2352 by 1568 pixels — 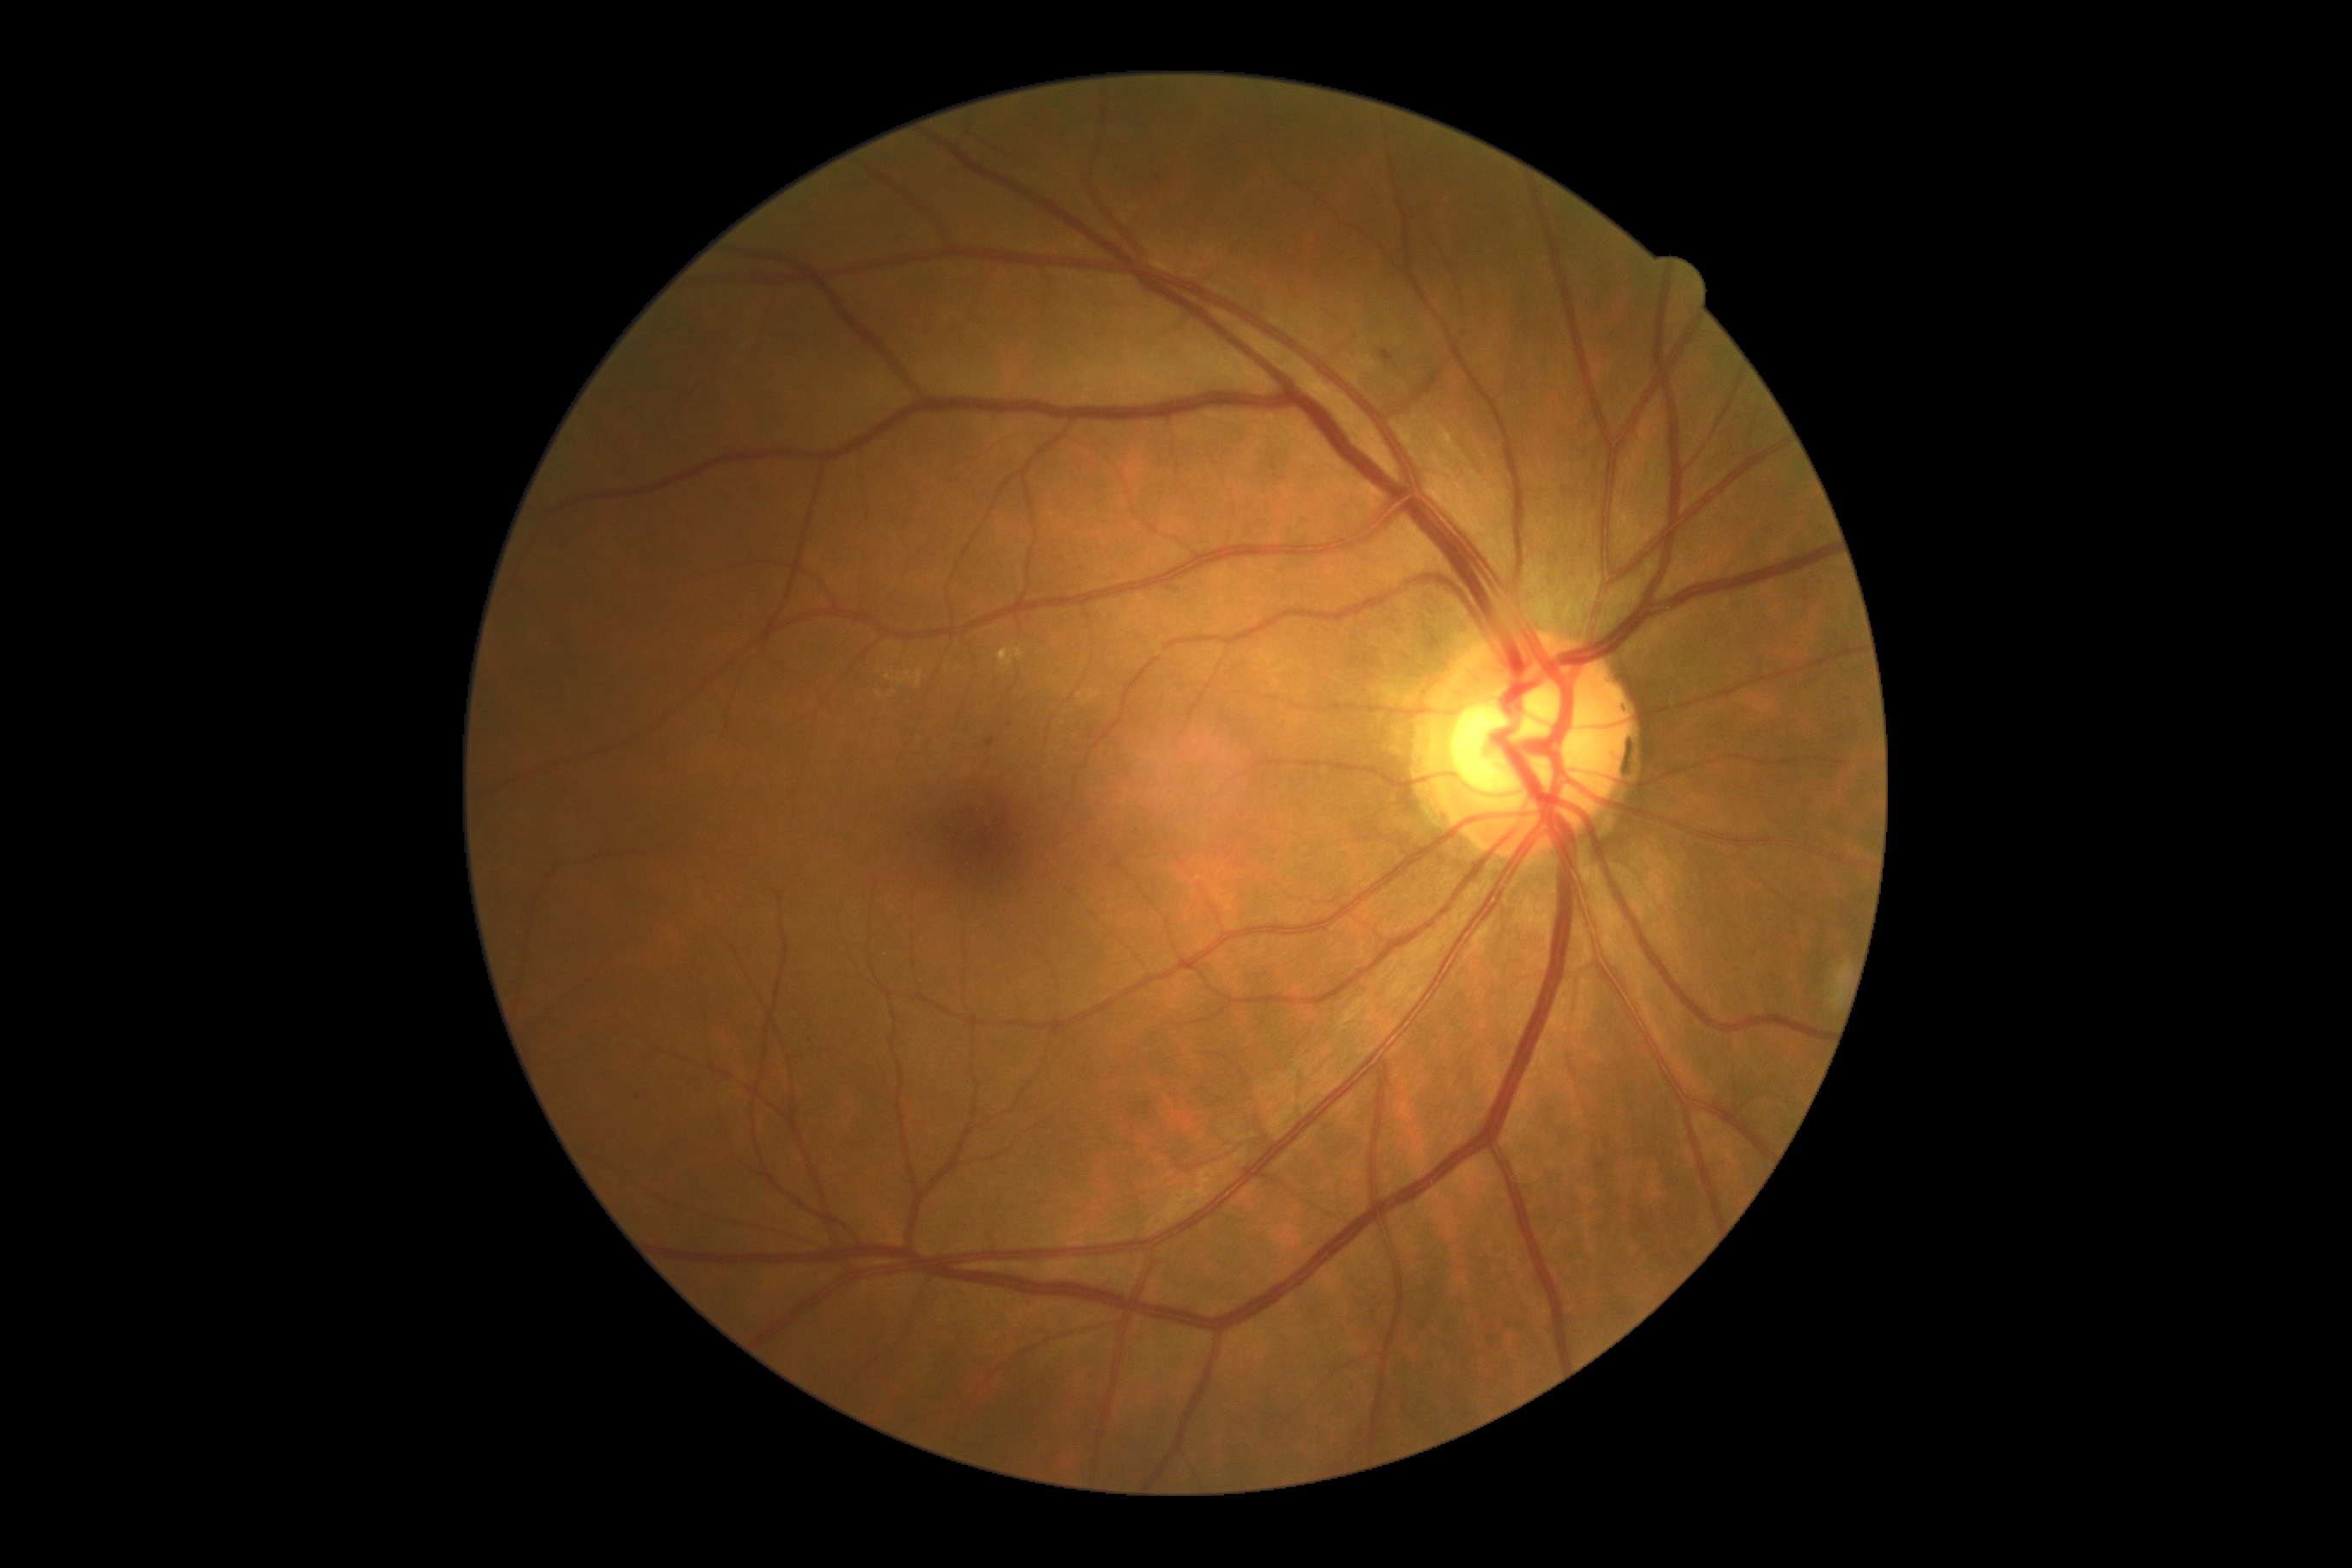 <lesions partial="true">
  <dr_grade>2</dr_grade>
  <ma partial="true">Rect(1381, 350, 1395, 365) | Rect(986, 738, 995, 749)</ma>
  <ma_small_approx><point>968, 730</point> | <point>637, 1097</point></ma_small_approx>
  <he />
  <ex partial="true">Rect(1017, 649, 1026, 659) | Rect(885, 673, 891, 682) | Rect(890, 690, 898, 697) | Rect(998, 649, 1014, 668) | Rect(914, 668, 922, 690) | Rect(895, 671, 912, 687)</ex>
  <ex_small_approx><point>960, 668</point> | <point>880, 693</point></ex_small_approx>
  <se />
</lesions>